Image size 2048x1536 · 45° field of view: 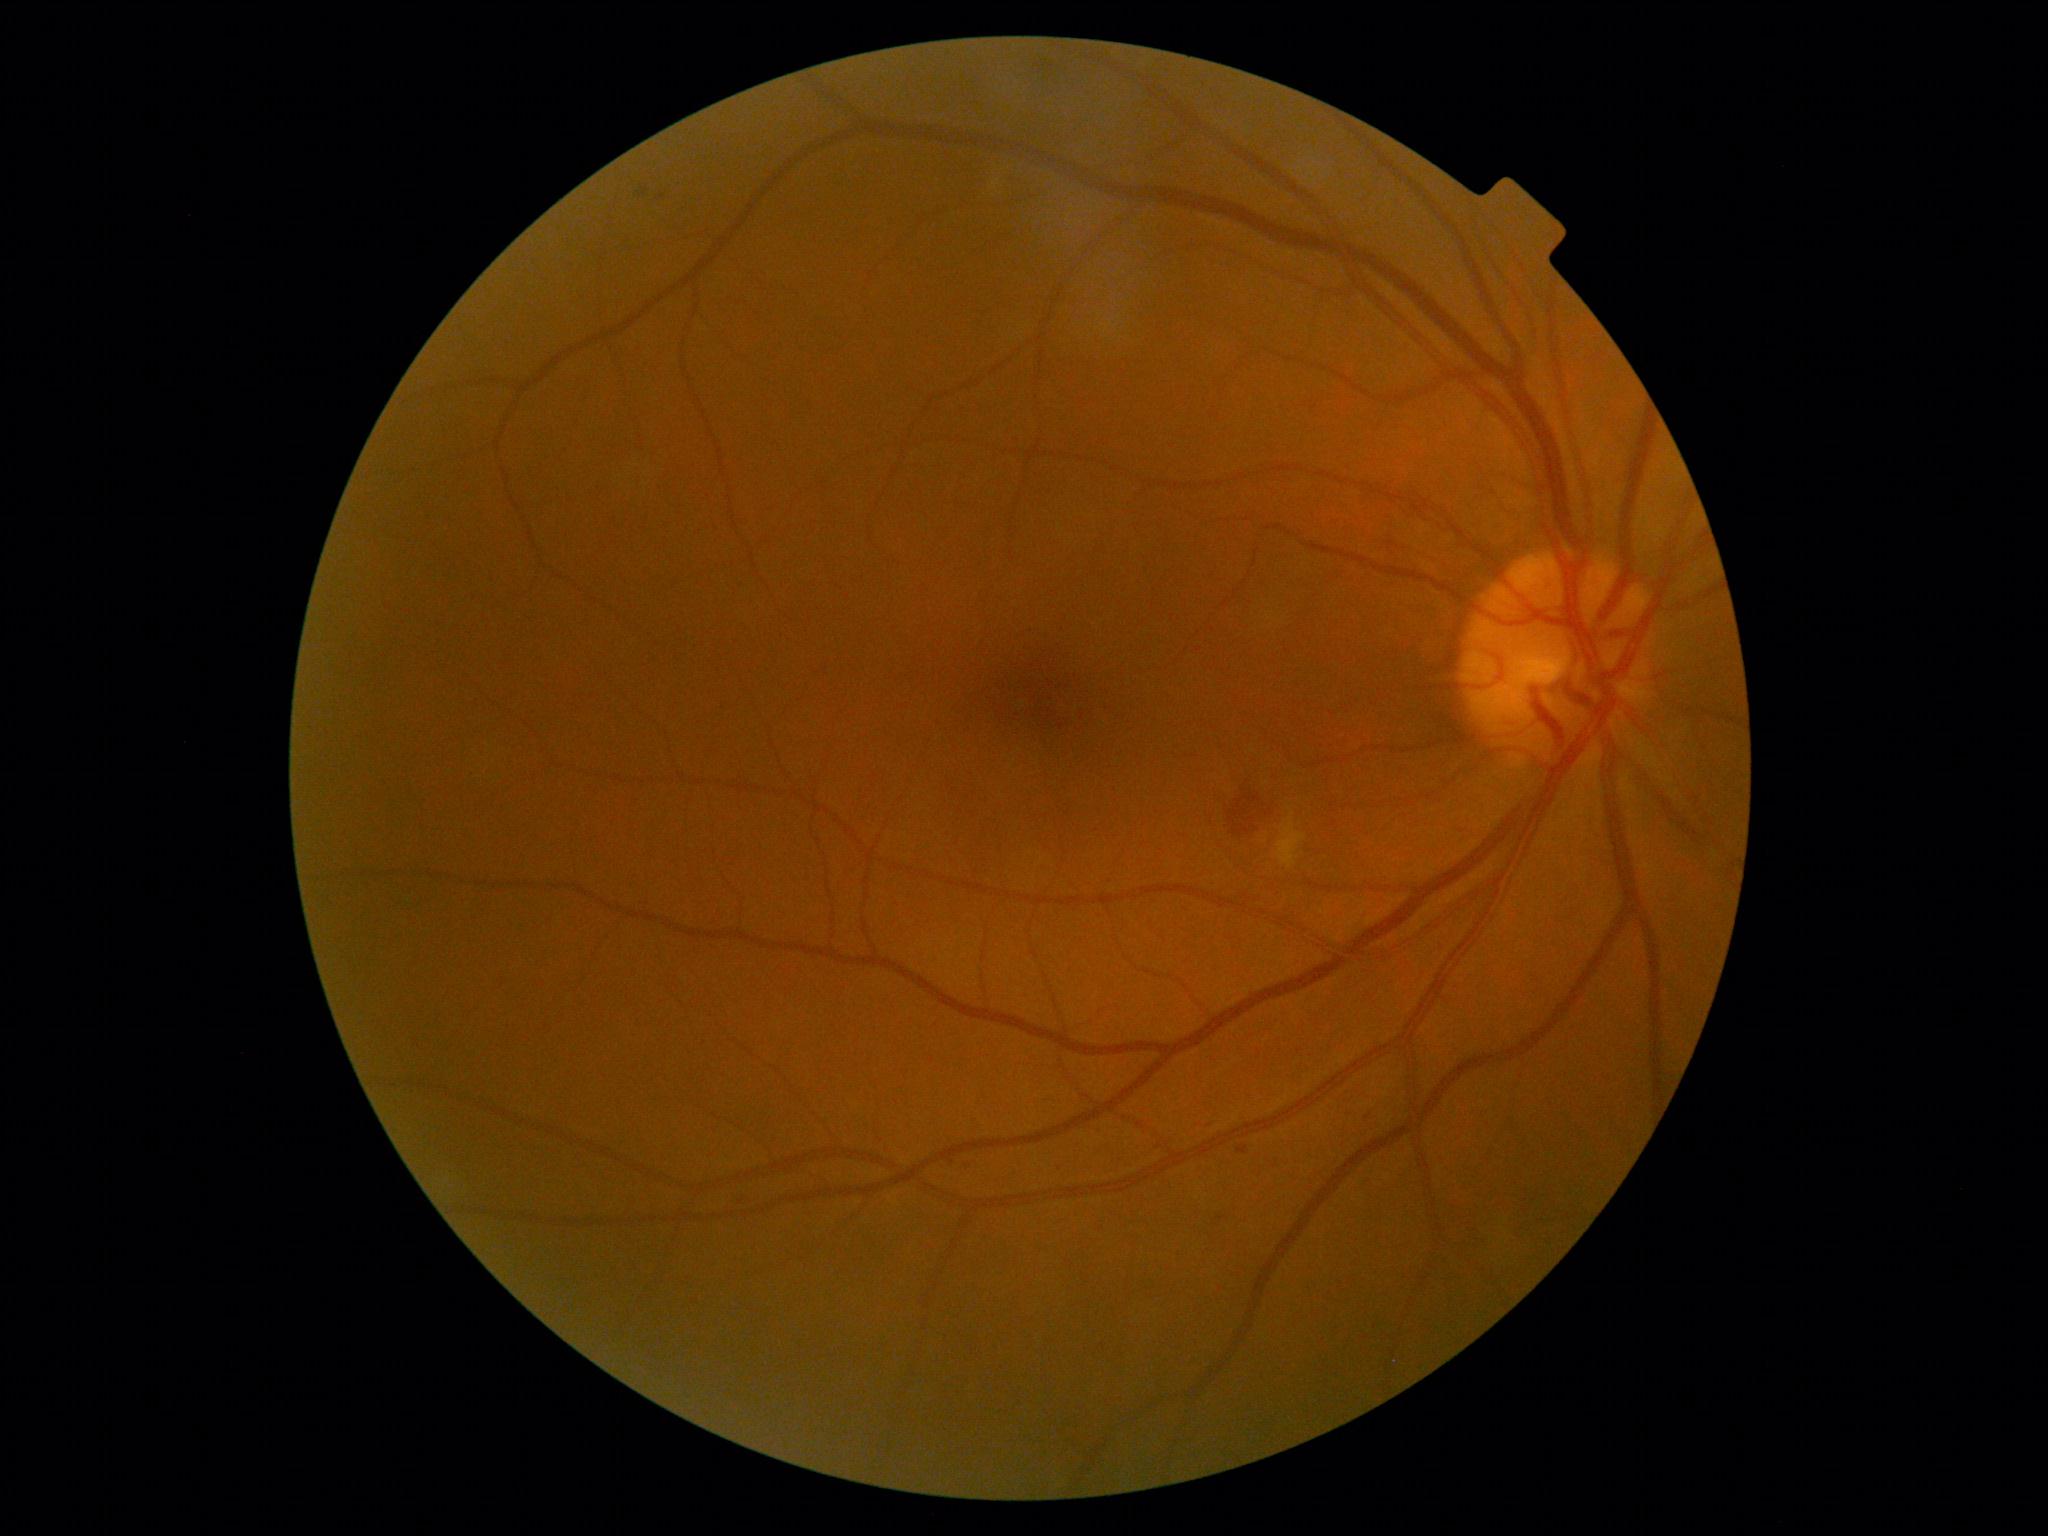

DR class: non-proliferative diabetic retinopathy, diabetic retinopathy (DR): moderate non-proliferative diabetic retinopathy (grade 2).